Wide-field fundus photograph from neonatal ROP screening. 640 by 480 pixels — 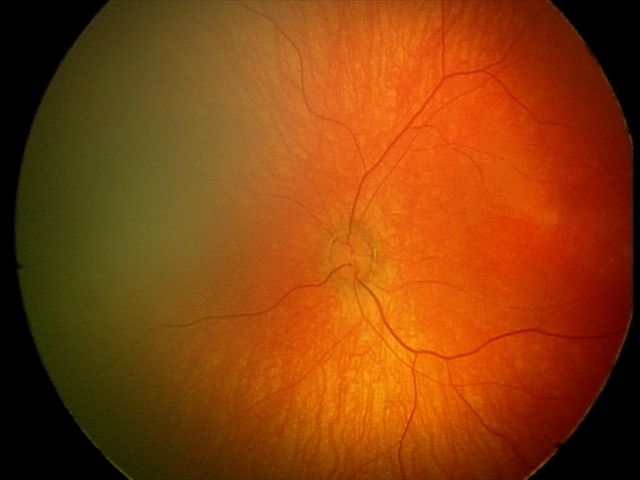
Screening: normal retinal appearance.